45-degree field of view:
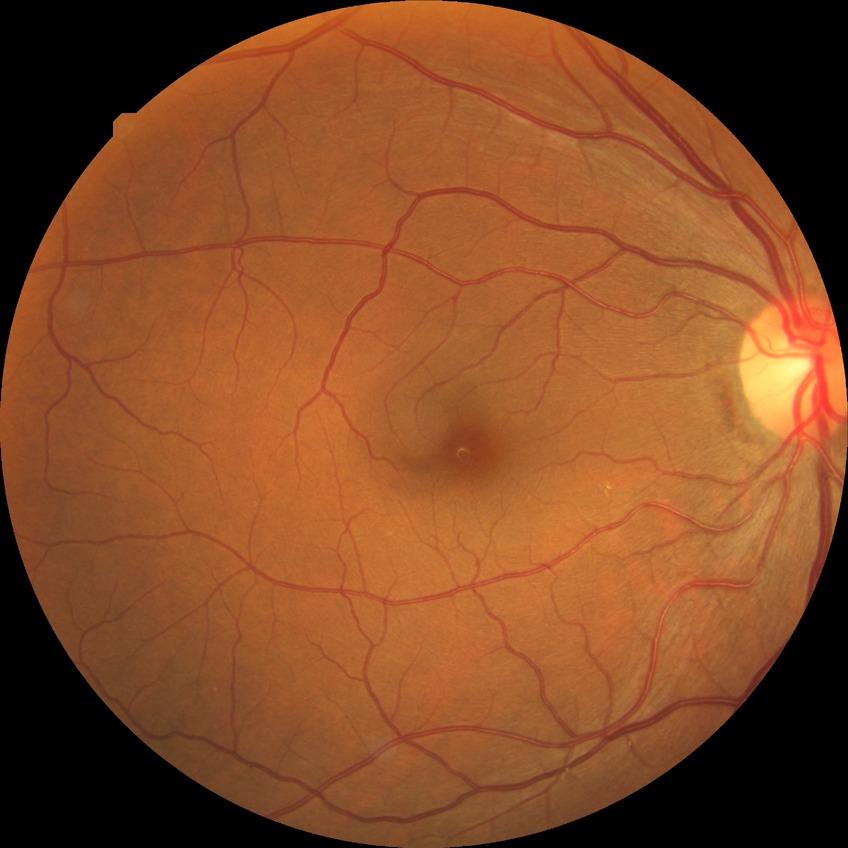 Diabetic retinopathy severity: no diabetic retinopathy.